Graded on the modified Davis scale; 848x848.
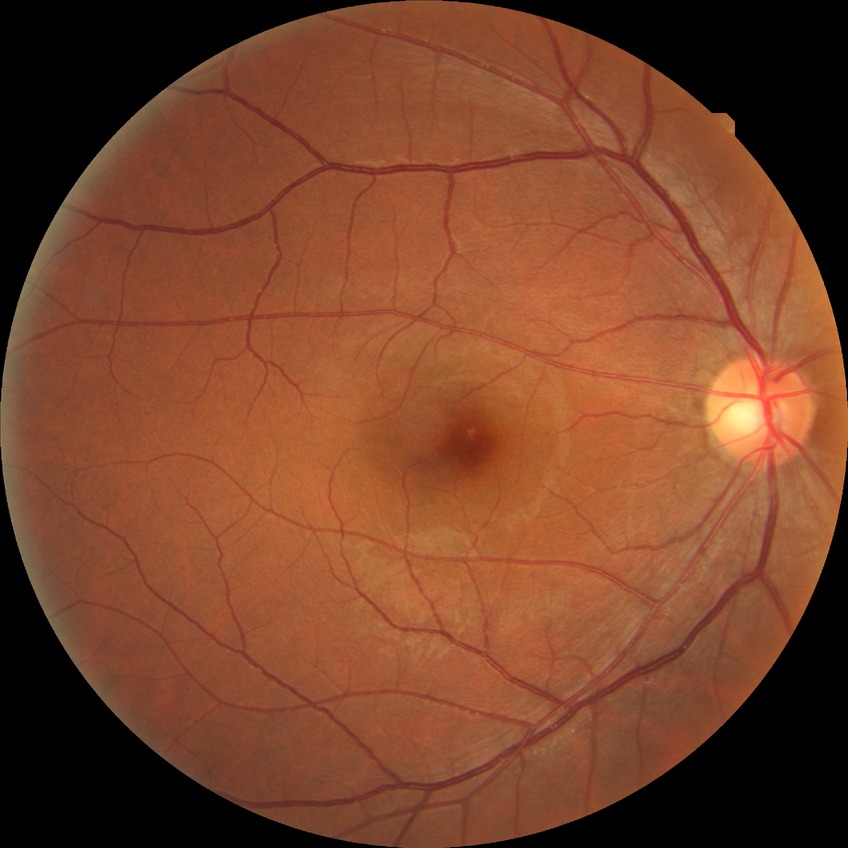

Modified Davis classification: no diabetic retinopathy.